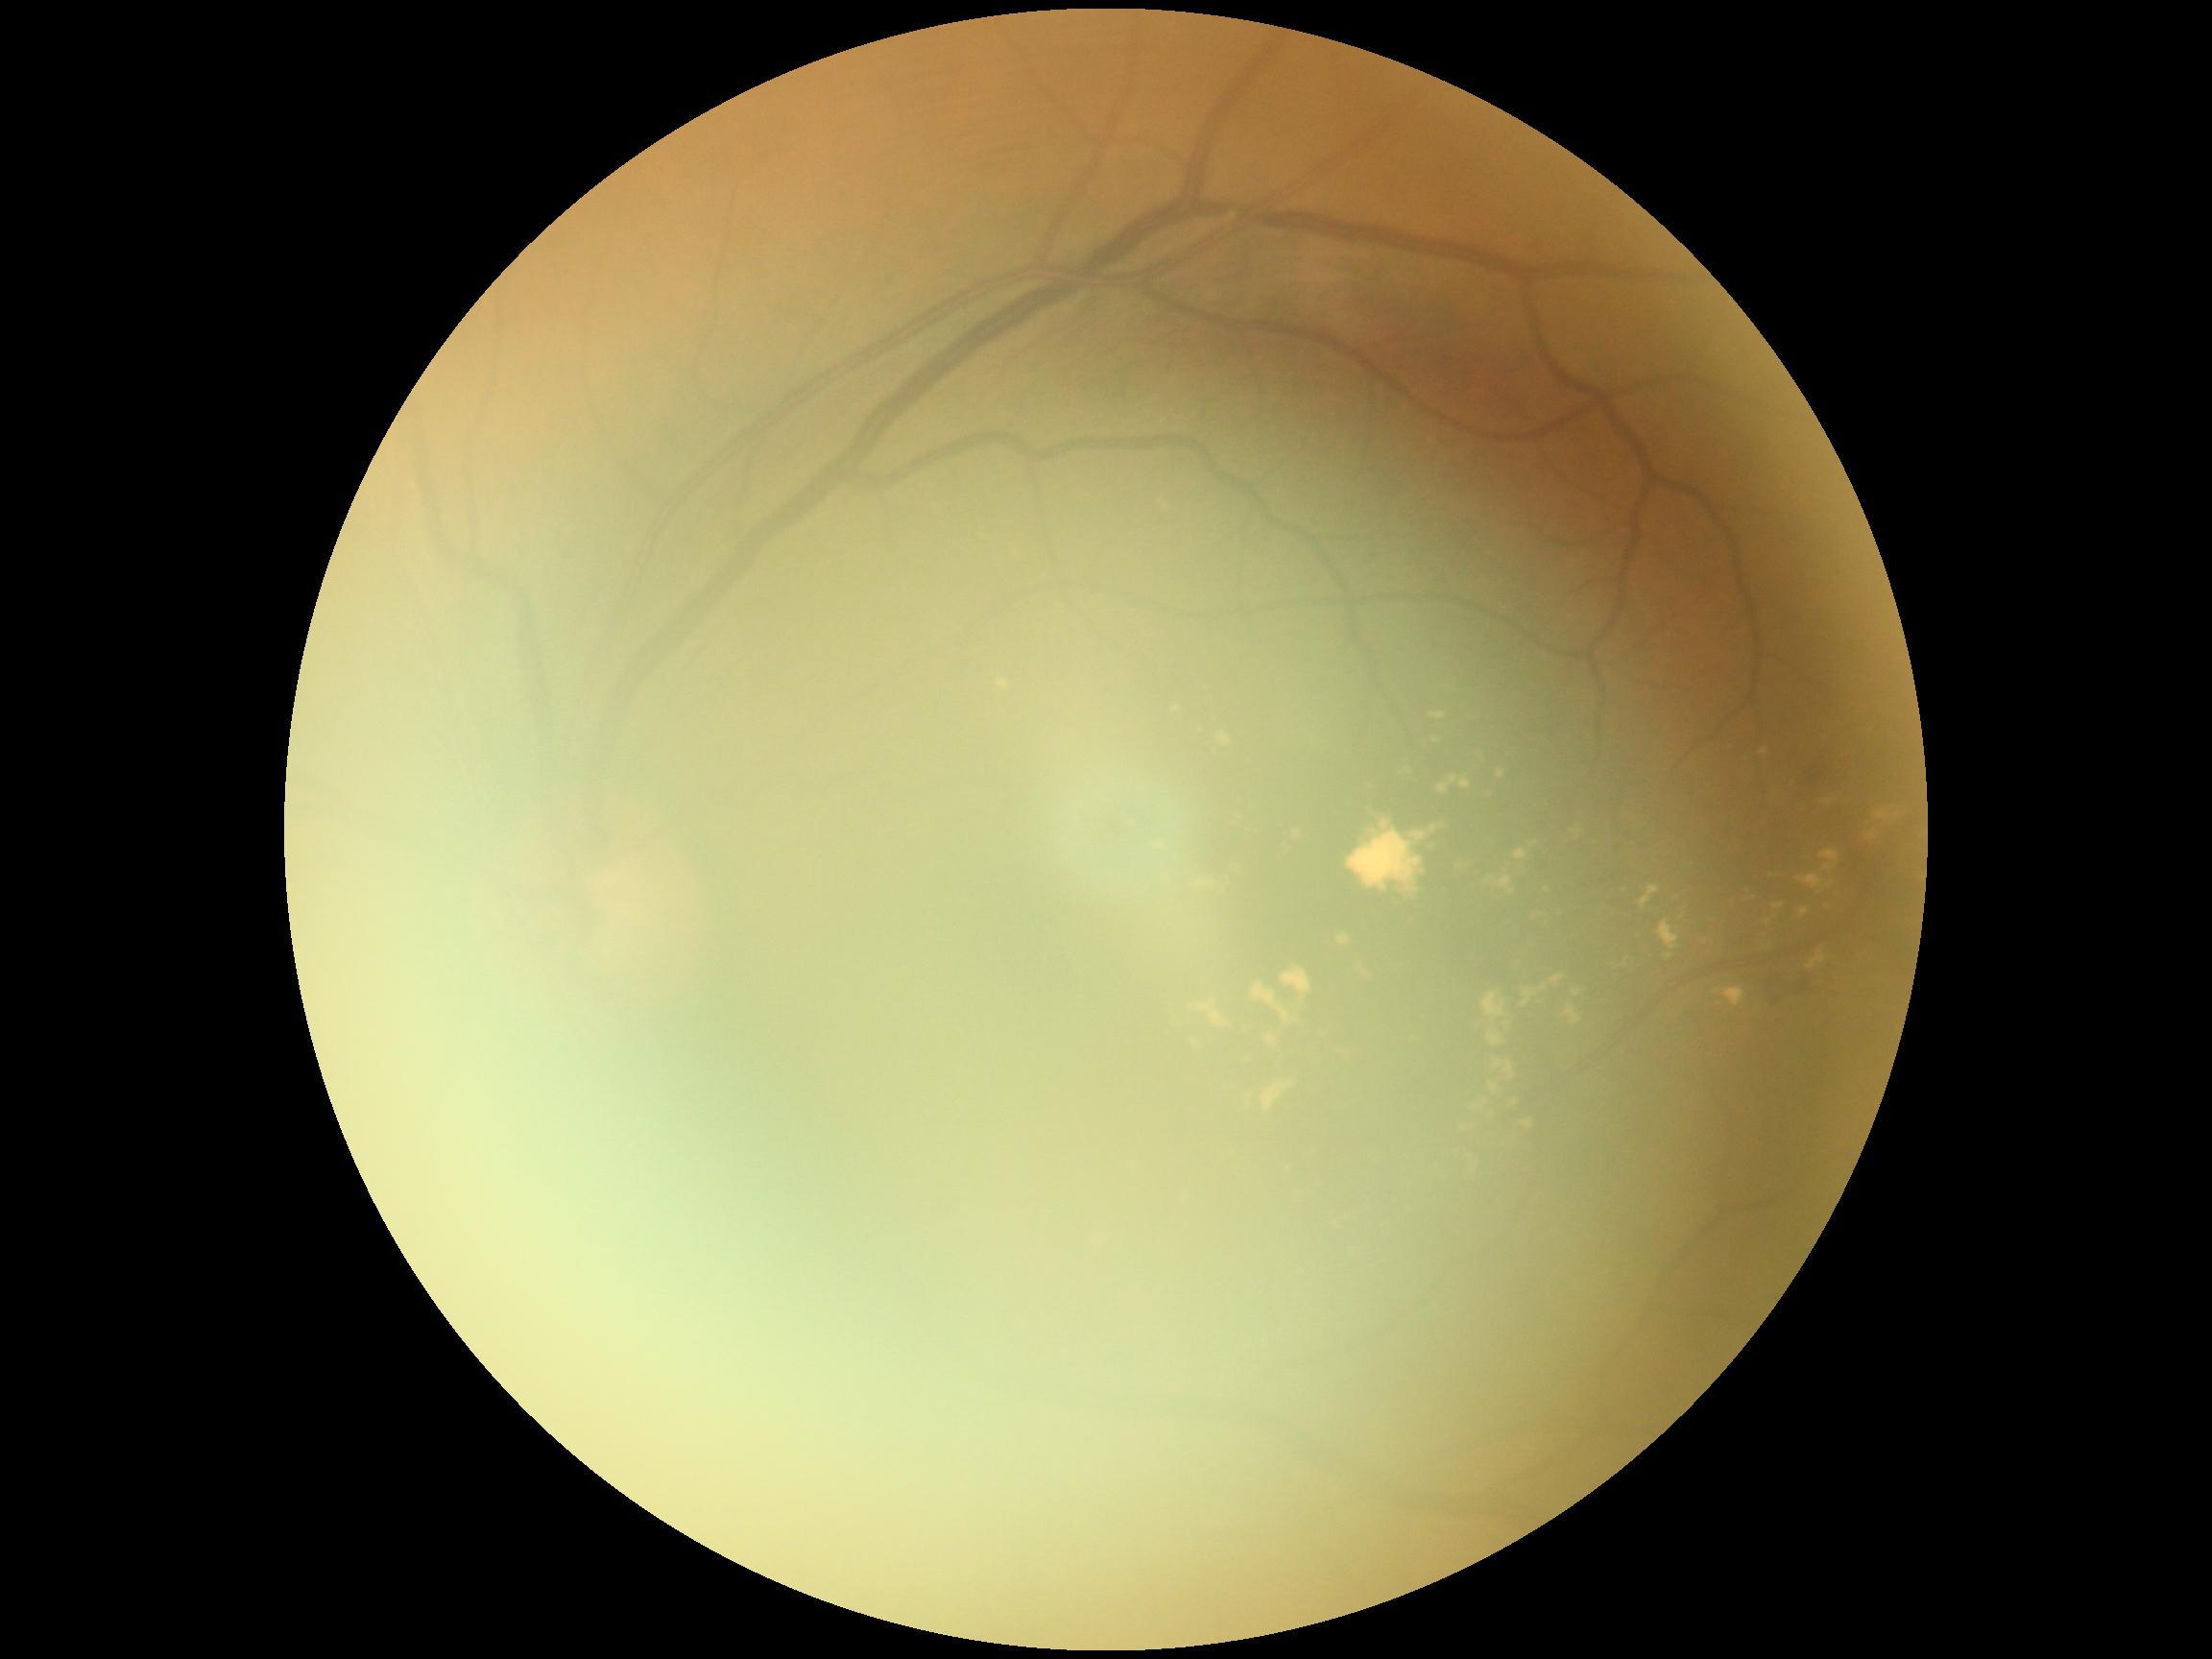

DR severity is moderate NPDR (grade 2) — more than just microaneurysms but less than severe NPDR.